Retinal fundus photograph; acquired with a NIDEK AFC-230.
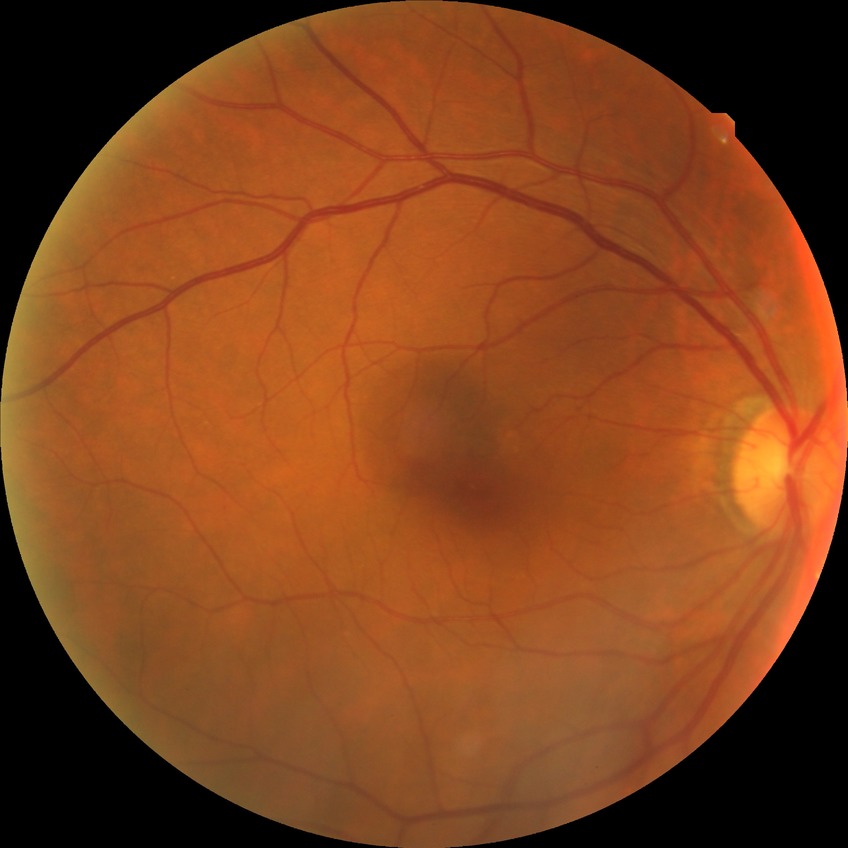

Diabetic retinopathy (DR): no diabetic retinopathy (NDR).